45° field of view · retinal fundus photograph · 1536x1152px — 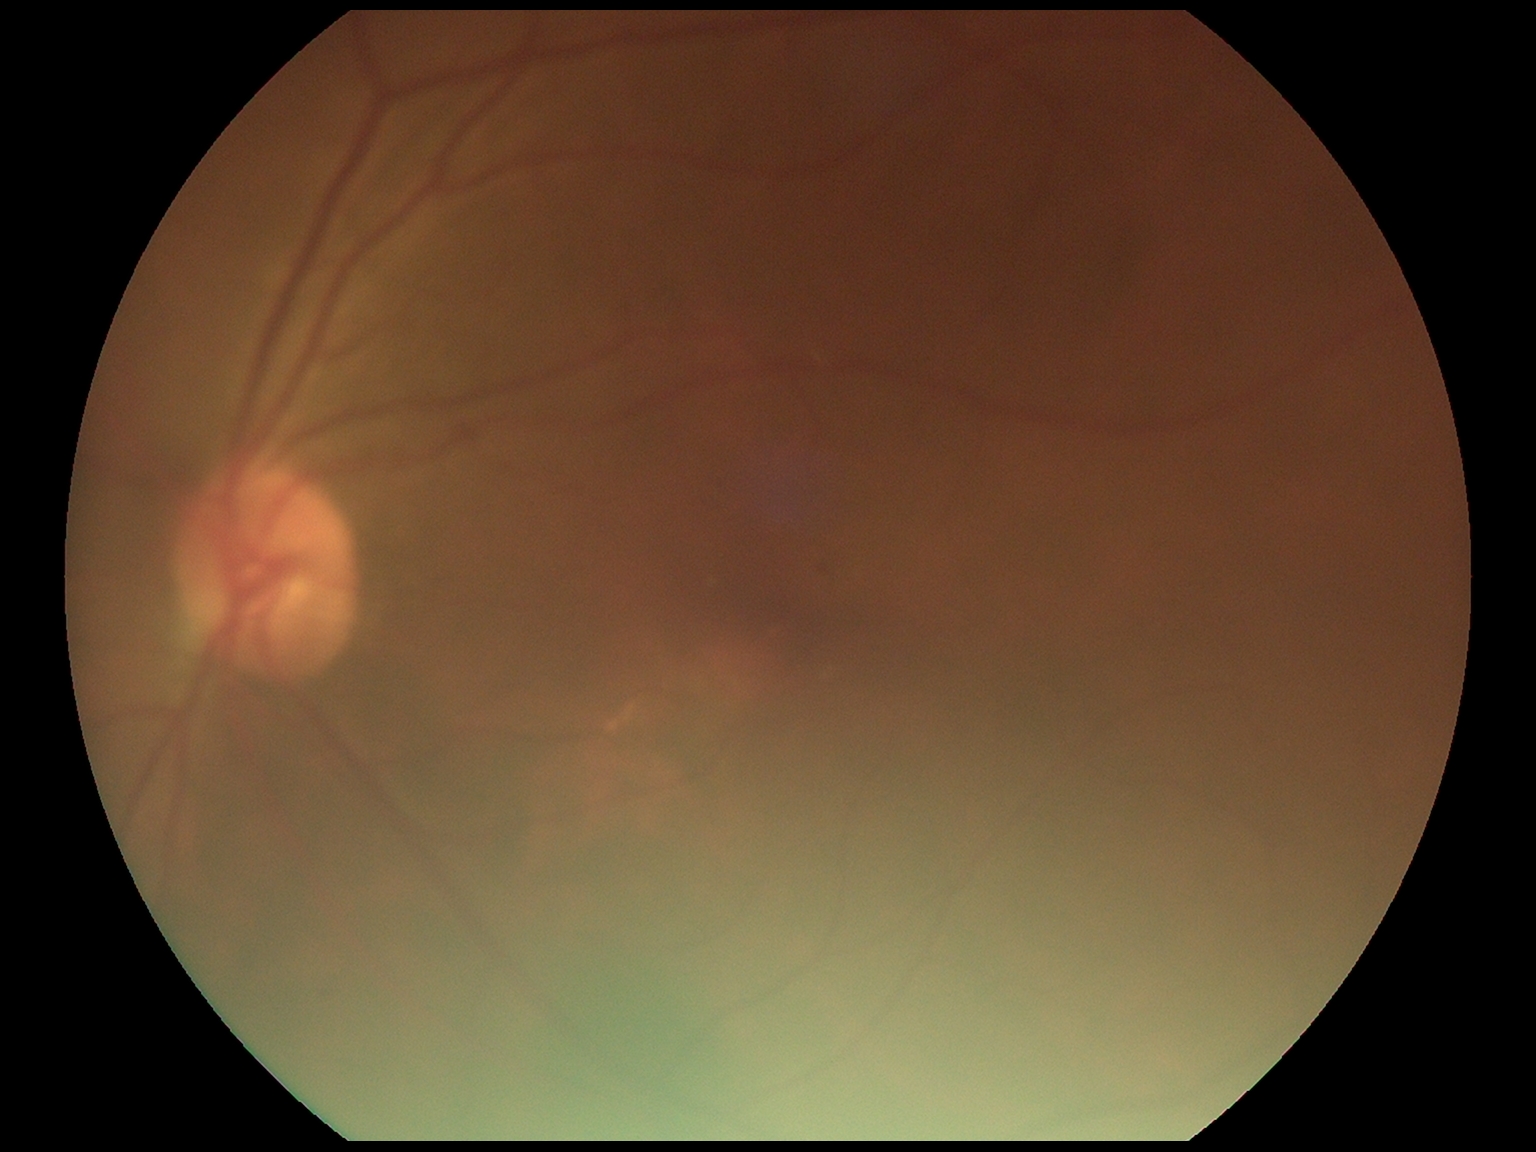
DR=1.